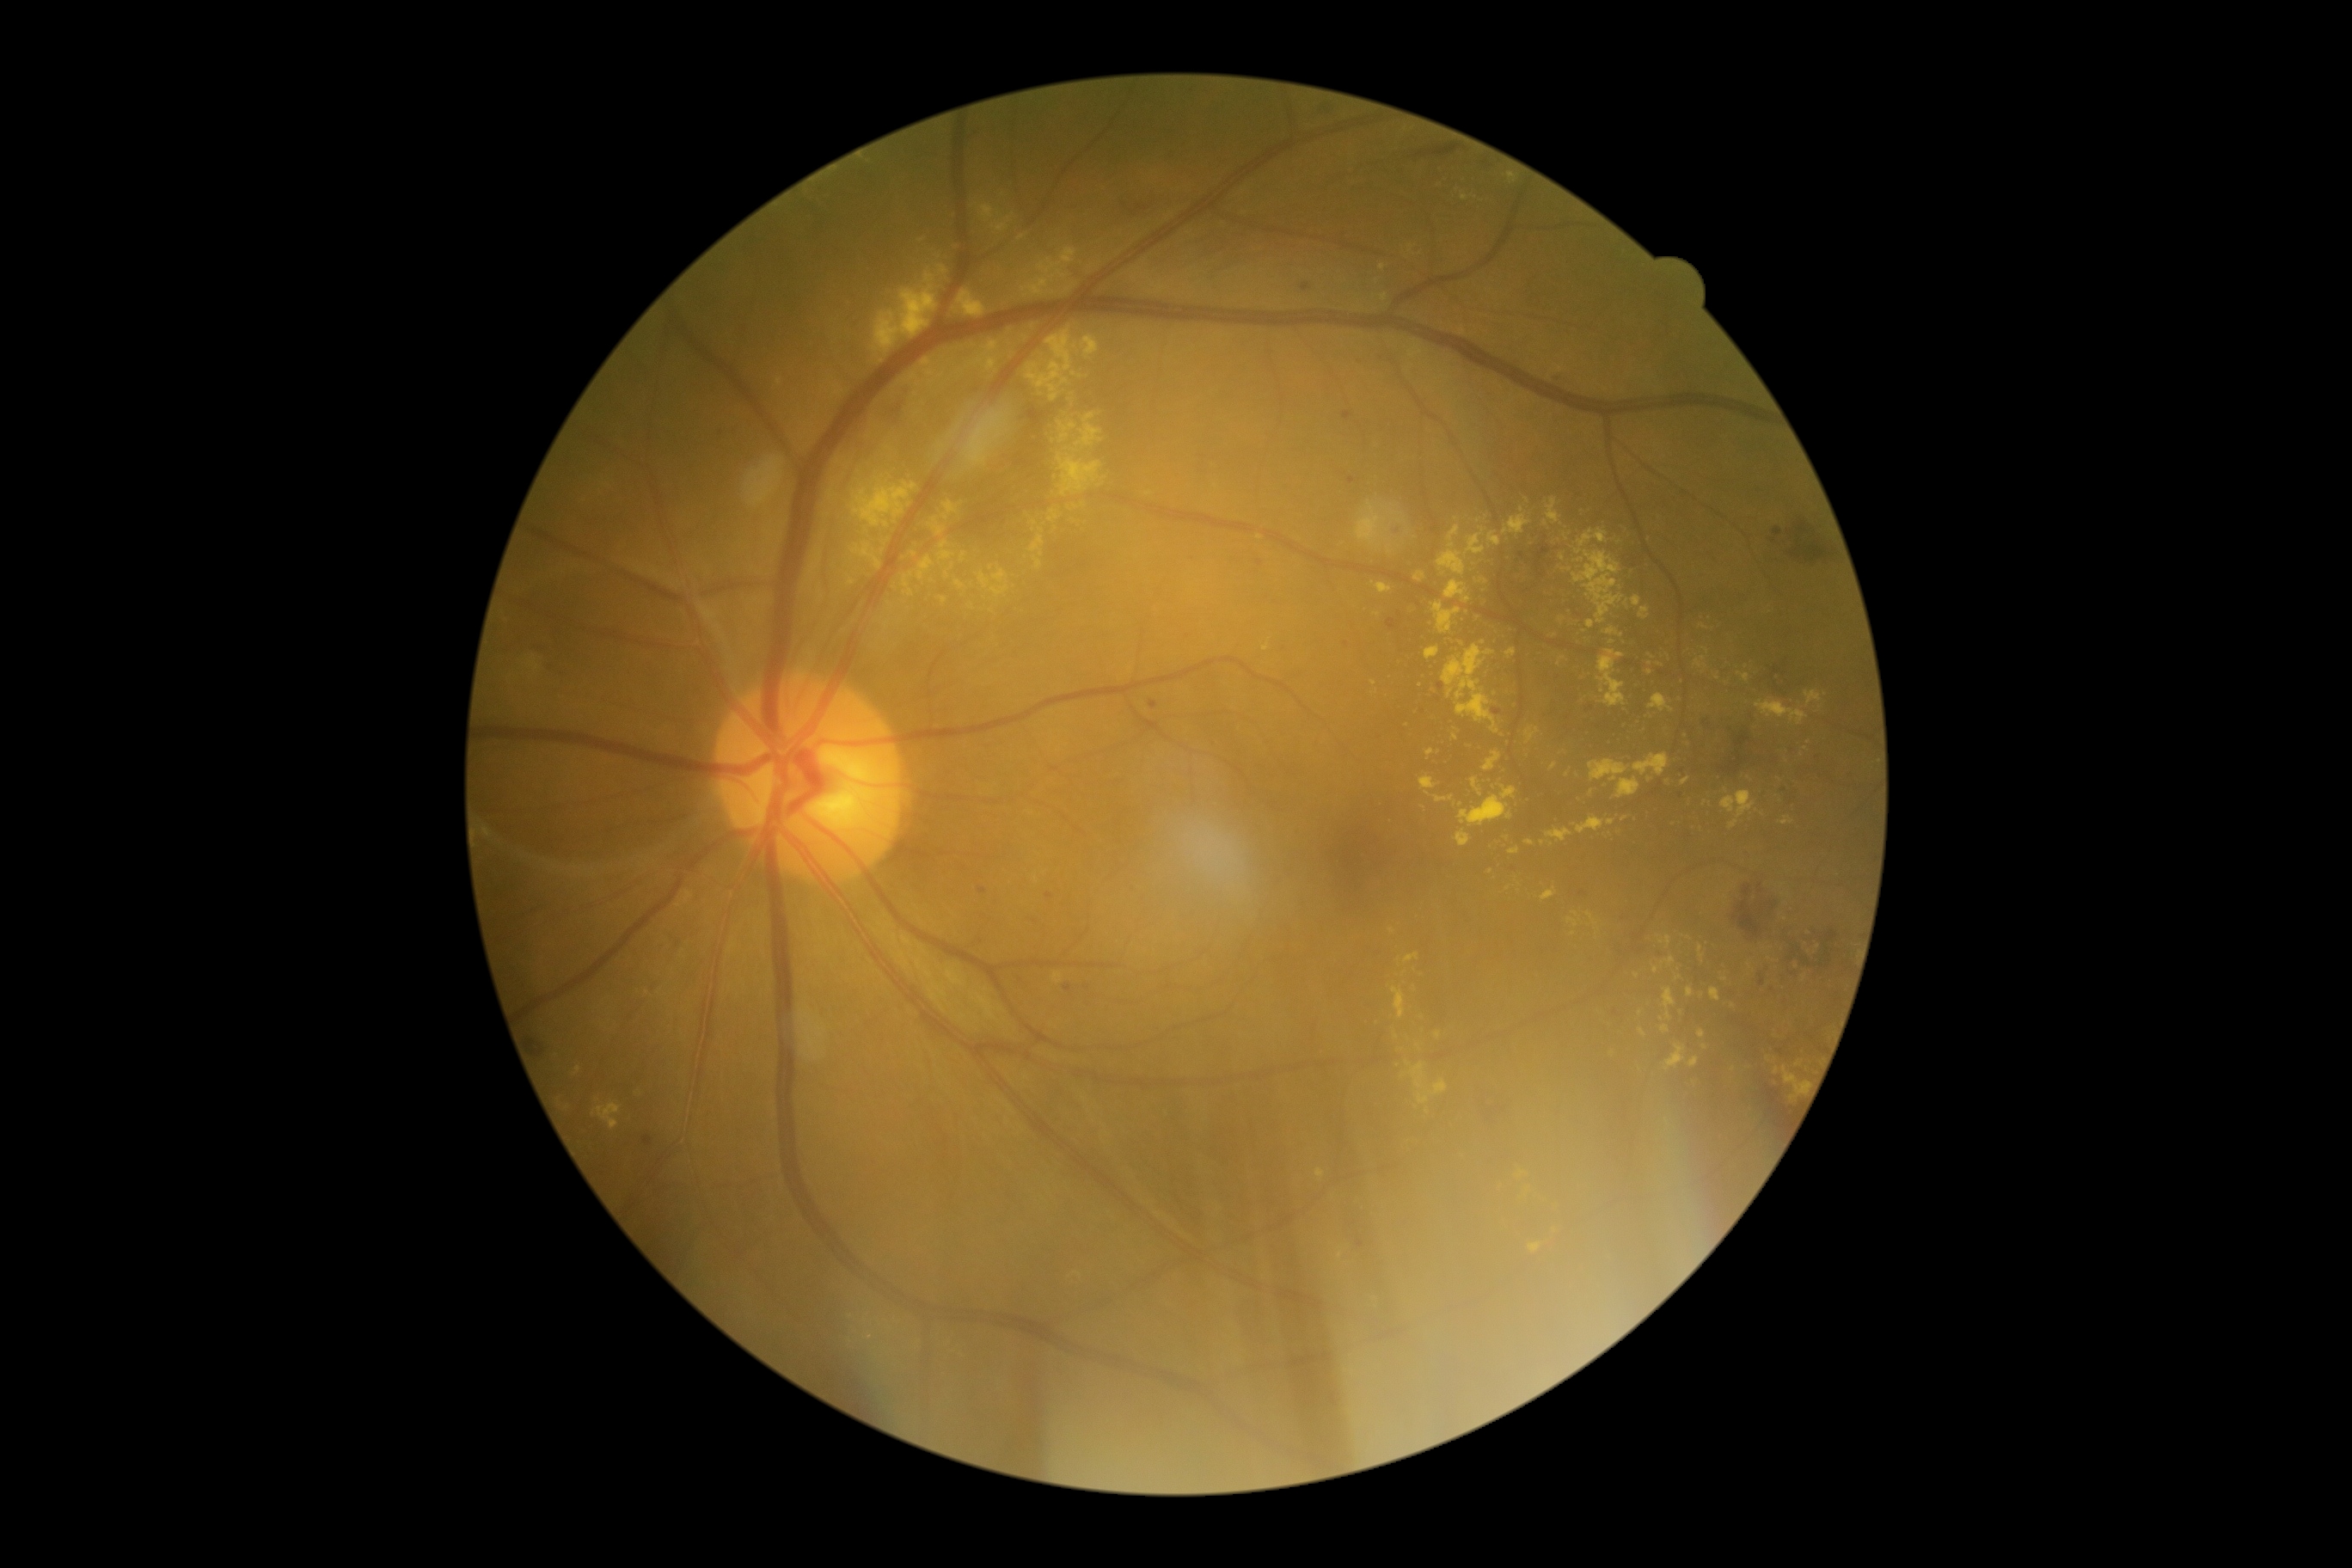

DR is grade 2 (moderate NPDR)
Selected lesions:
EXs (subset): left=1588, top=622, right=1595, bottom=630 | left=1650, top=694, right=1674, bottom=713 | left=1547, top=499, right=1560, bottom=524 | left=1065, top=283, right=1077, bottom=293 | left=1526, top=726, right=1540, bottom=744 | left=592, top=1103, right=622, bottom=1130 | left=1438, top=525, right=1466, bottom=575 | left=1442, top=644, right=1500, bottom=733 | left=1729, top=819, right=1739, bottom=830 | left=1682, top=776, right=1691, bottom=785 | left=979, top=573, right=991, bottom=589
EXs (small, approximate centers) near {"x": 915, "y": 394} | {"x": 953, "y": 567} | {"x": 1383, "y": 268} | {"x": 1465, "y": 196} | {"x": 1727, "y": 791} | {"x": 1569, "y": 570} | {"x": 1650, "y": 672} | {"x": 1428, "y": 1111} | {"x": 887, "y": 624}